Nonmydriatic. DR severity per modified Davis staging. 848x848px — 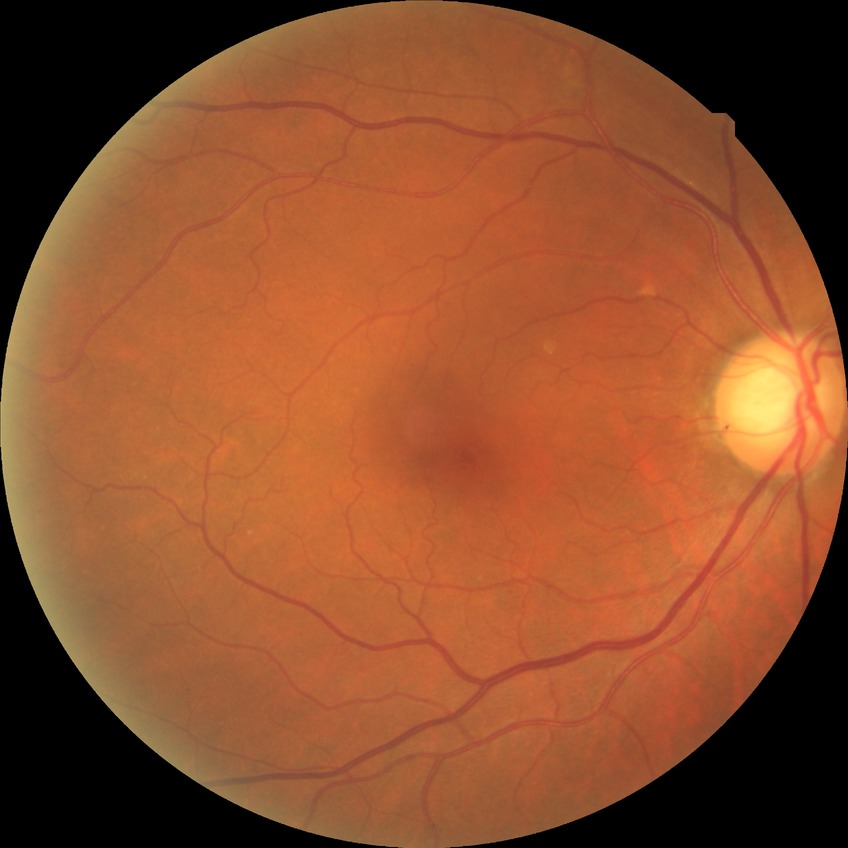 Diabetic retinopathy (DR): NDR (no diabetic retinopathy).